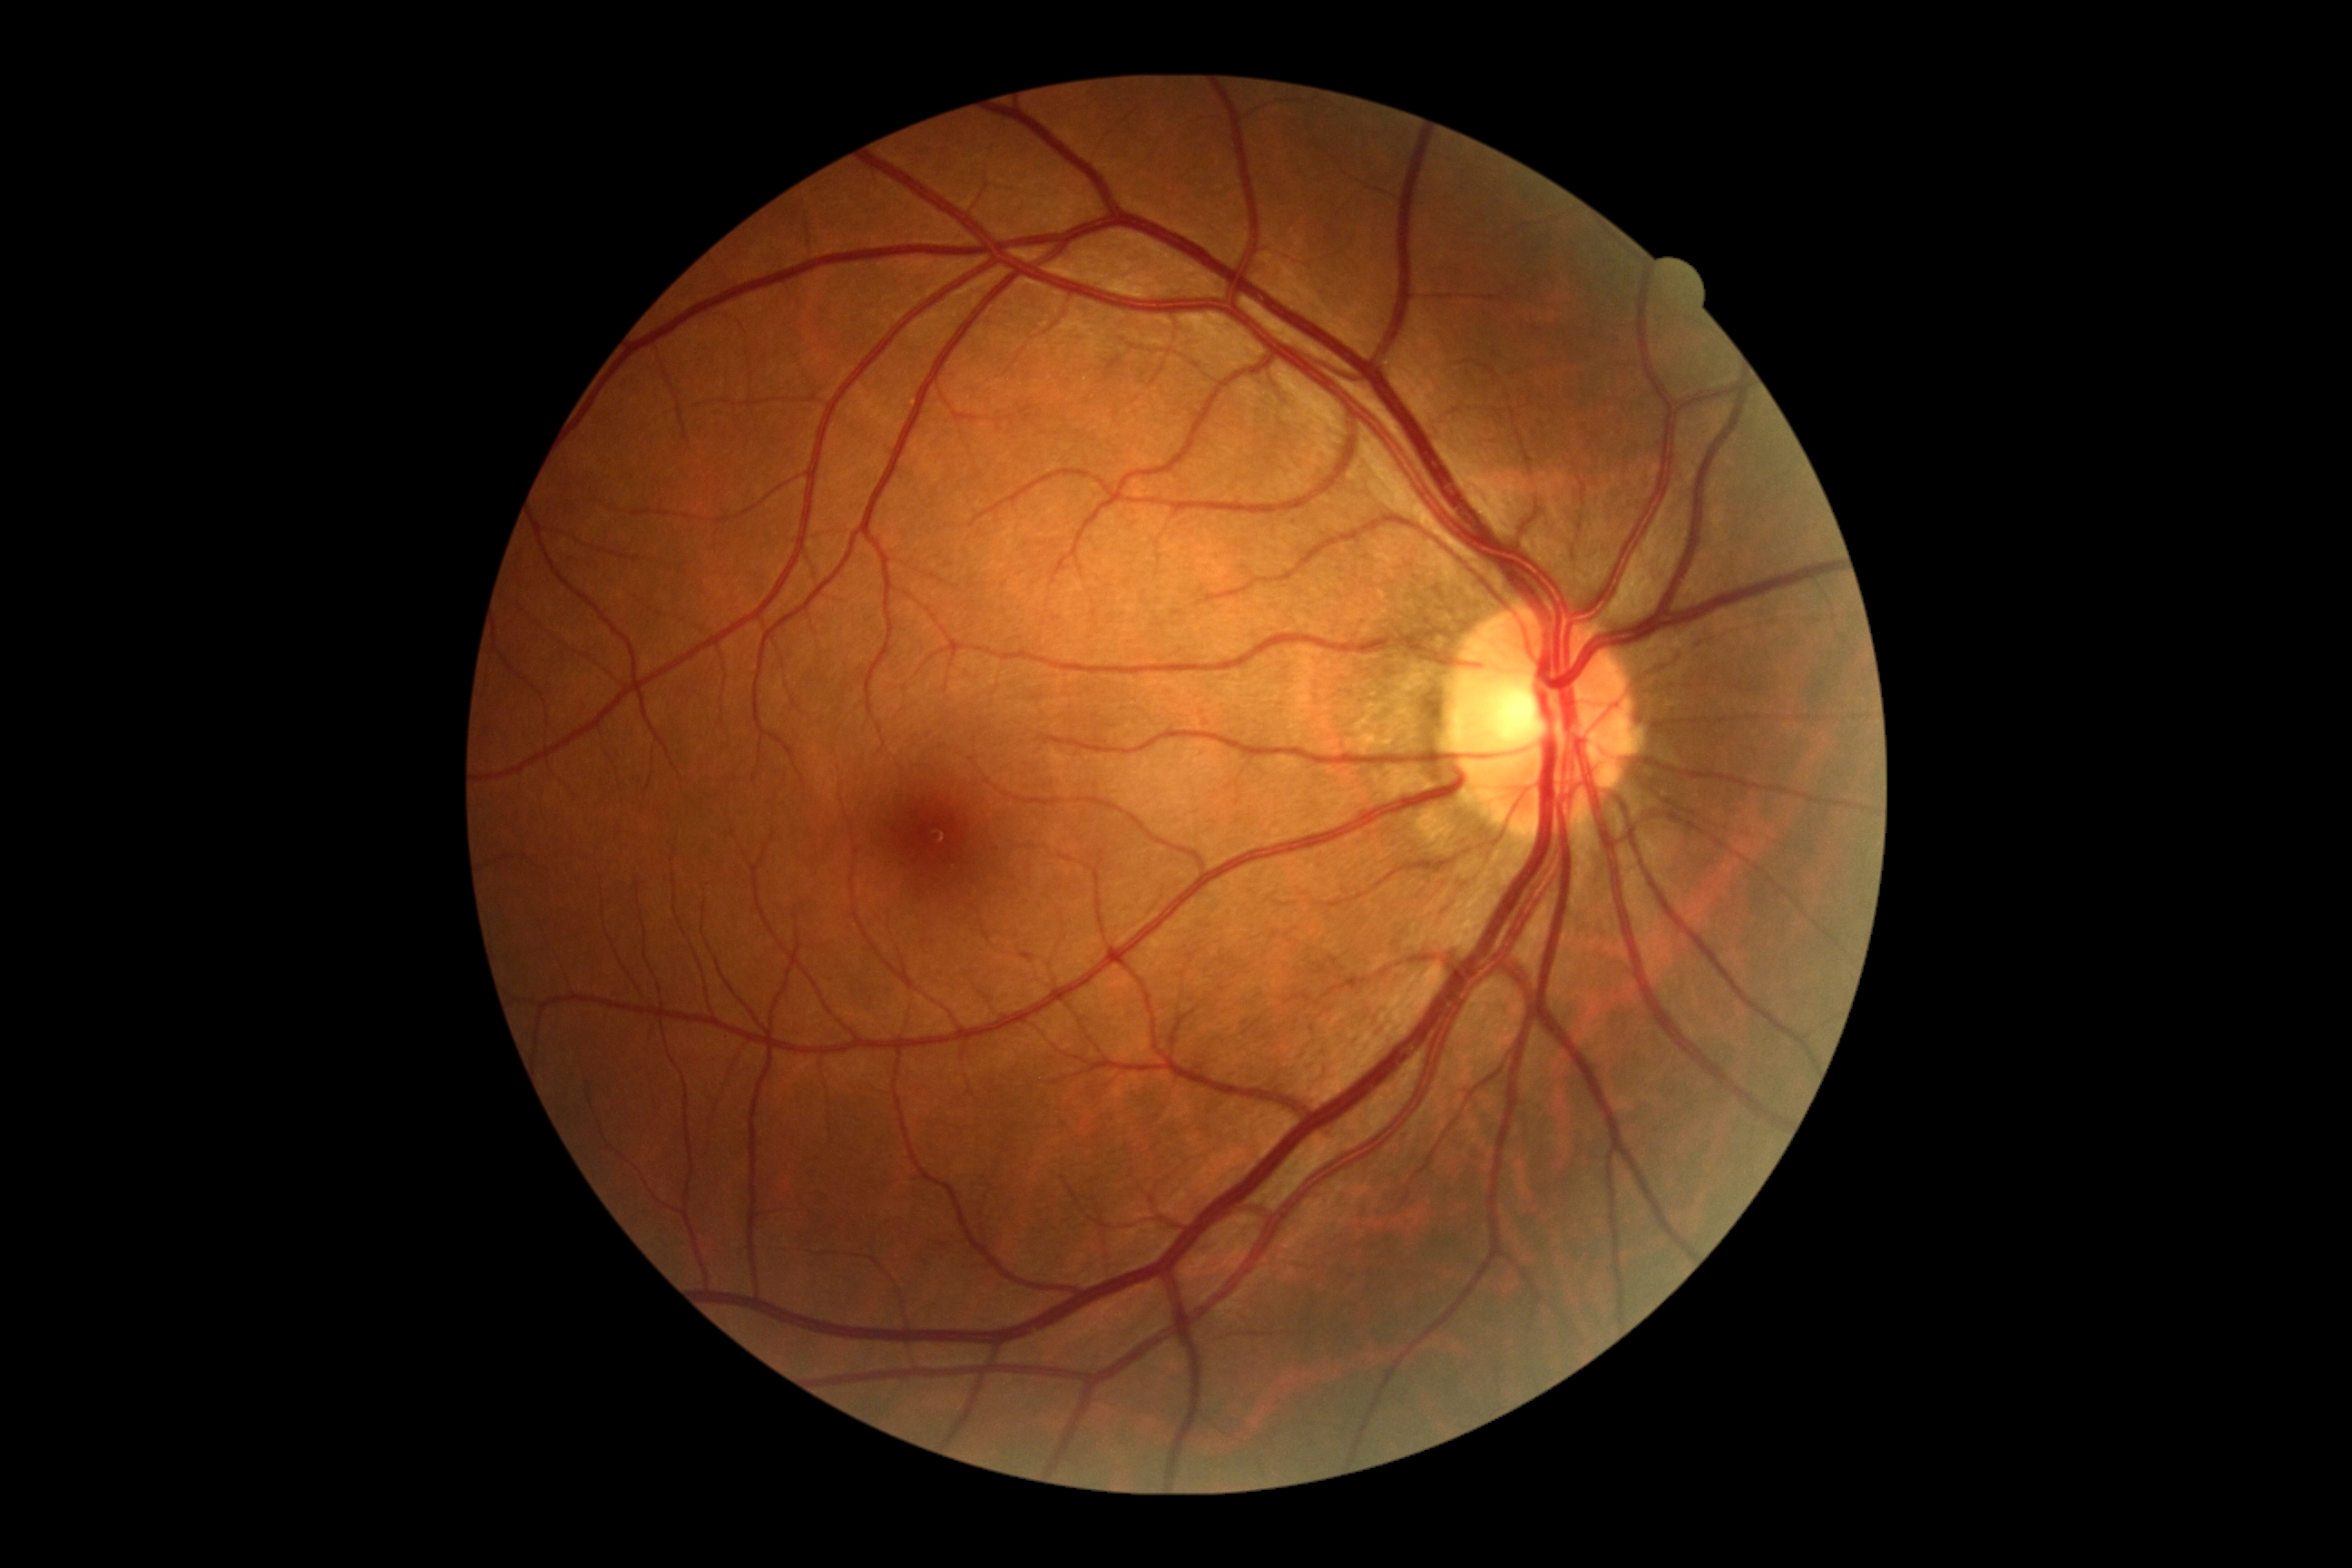

Annotations:
- DR impression: no DR findings
- diabetic retinopathy (DR): grade 0